Color fundus photograph · NIDEK AFC-230:
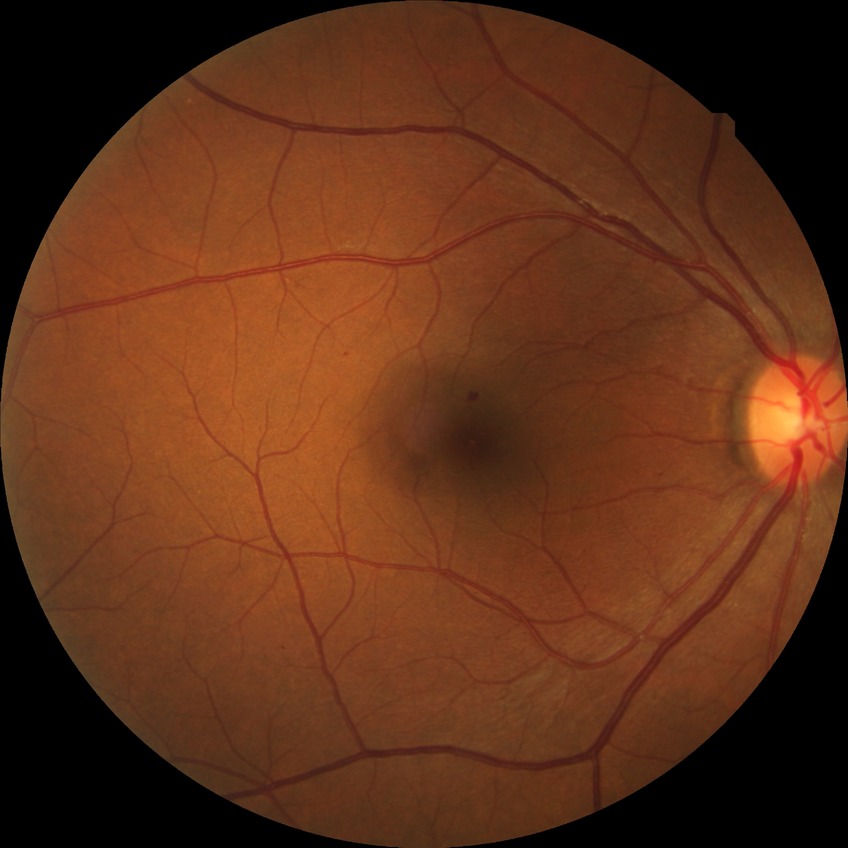
Diabetic retinopathy (DR) is SDR (simple diabetic retinopathy).